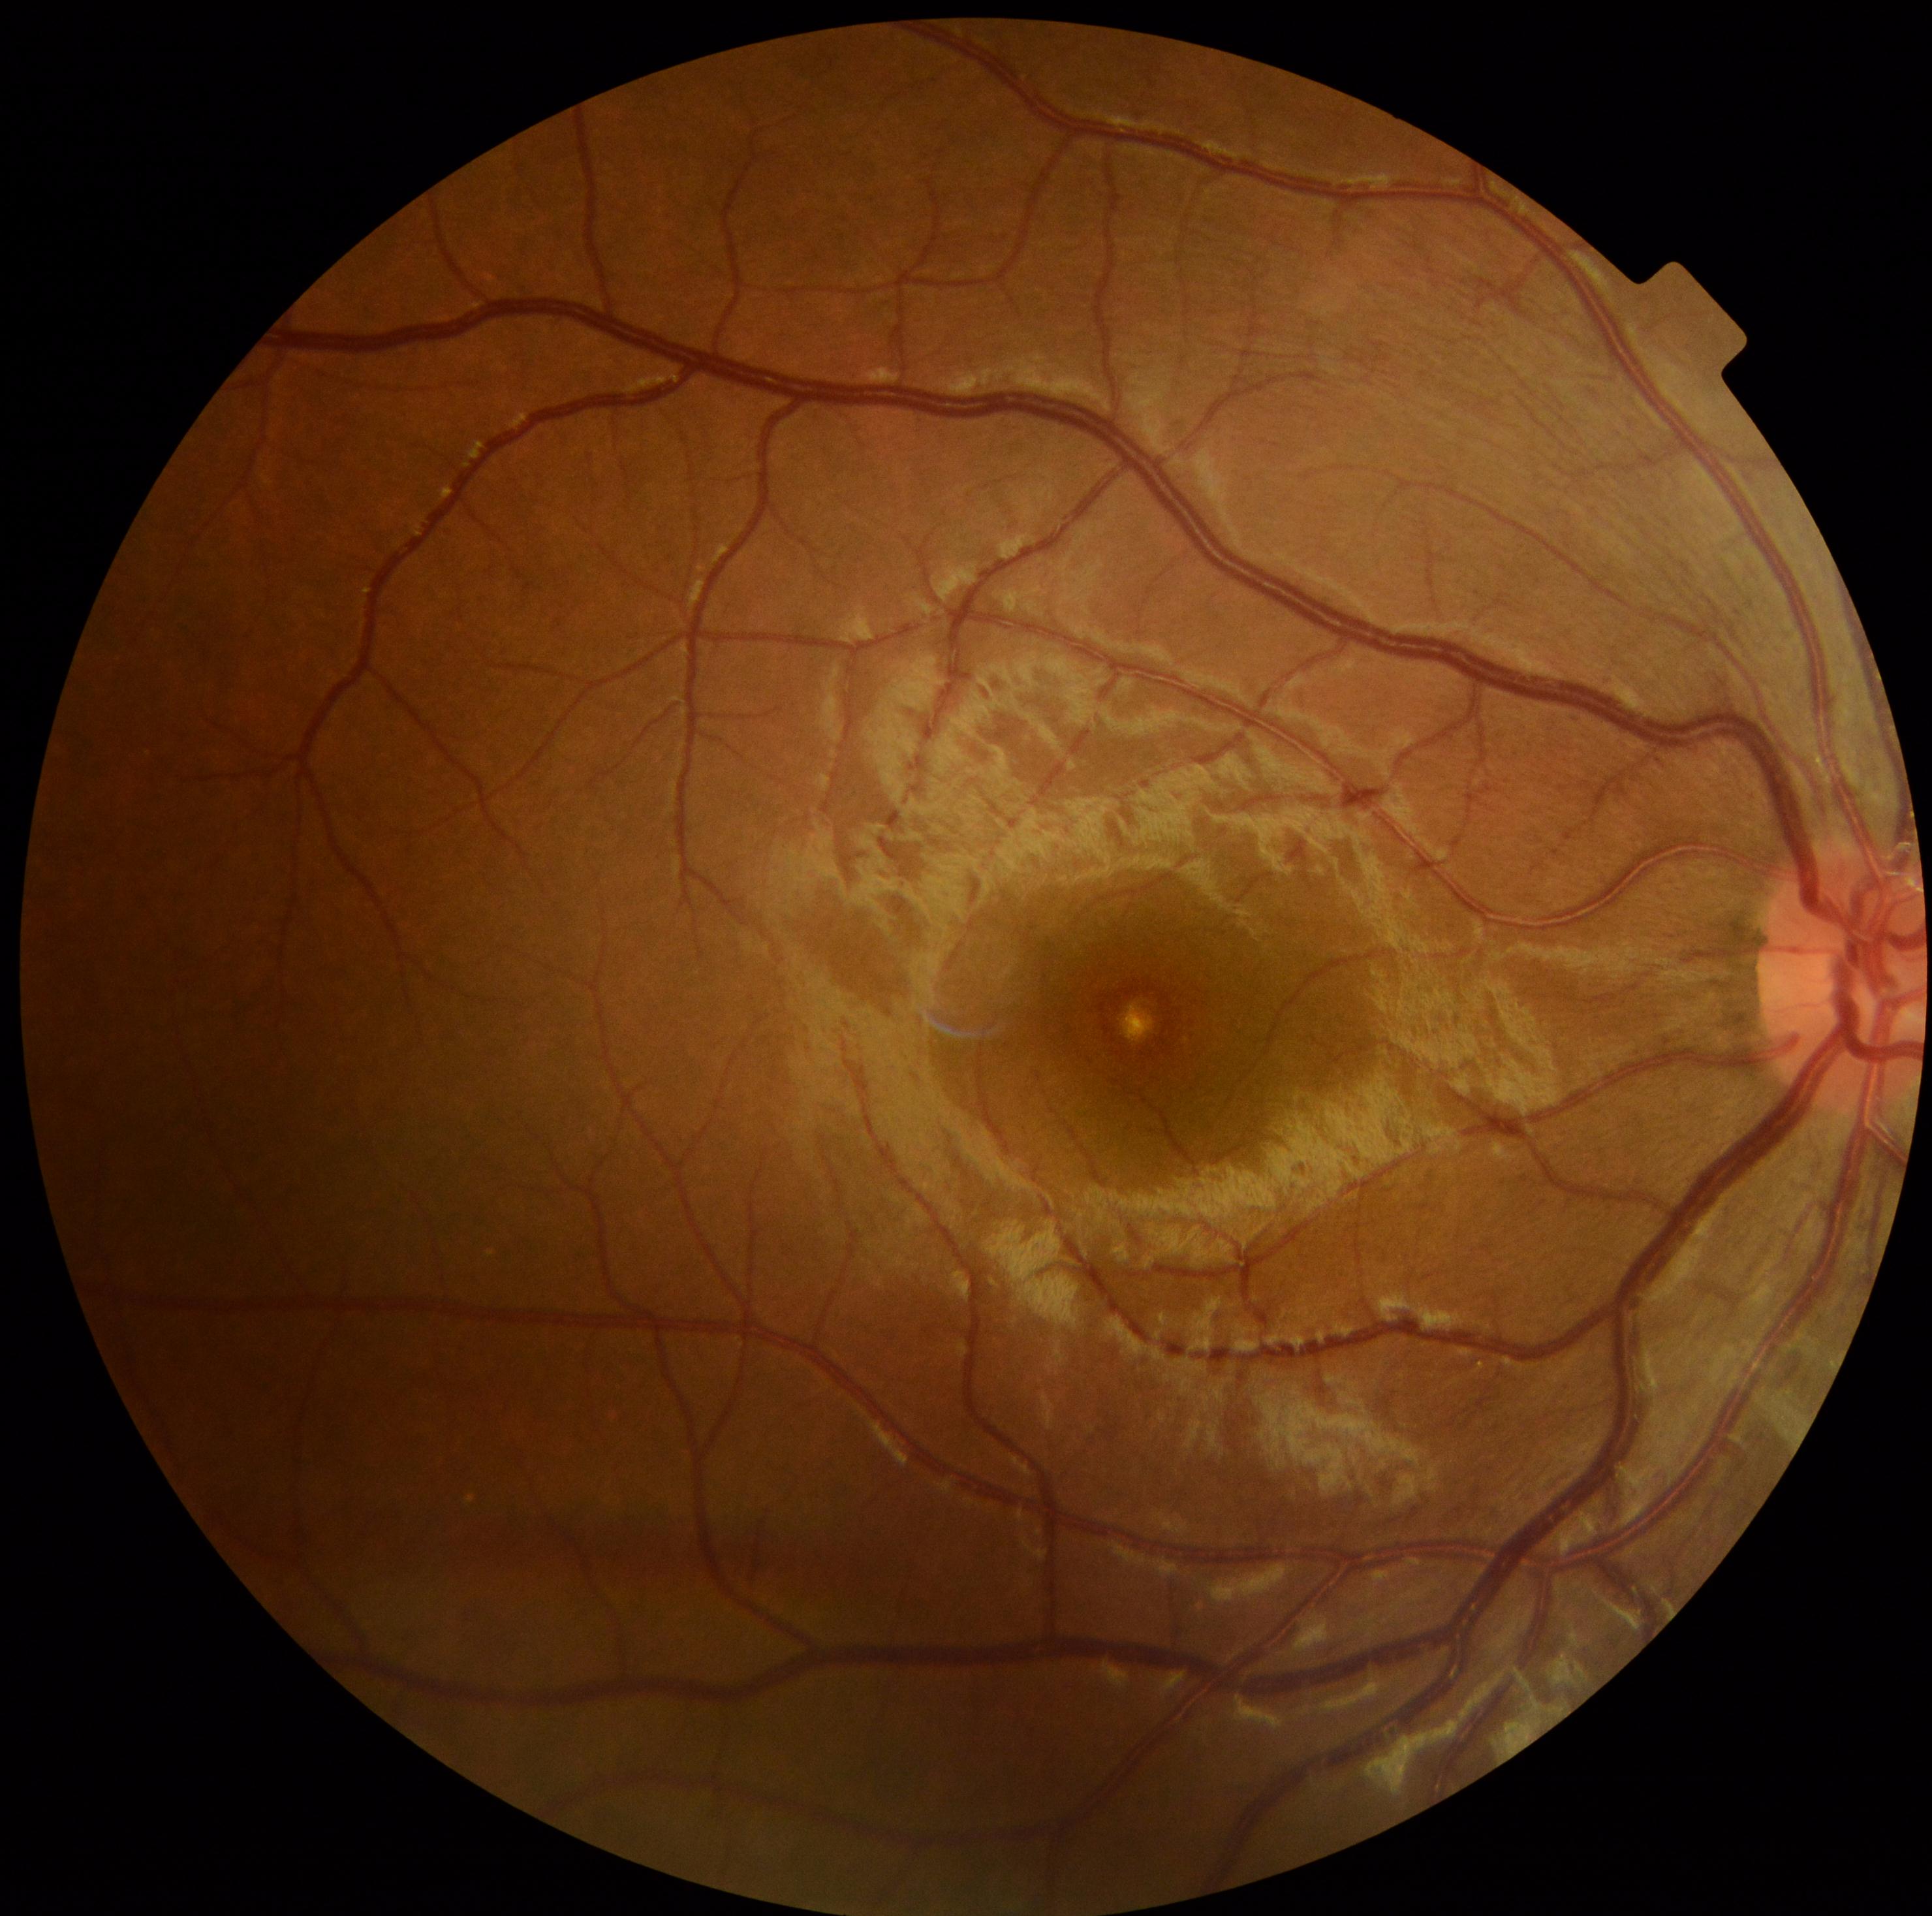   dr_impression: no signs of DR
  dr_grade: 0